Pediatric wide-field fundus photograph: 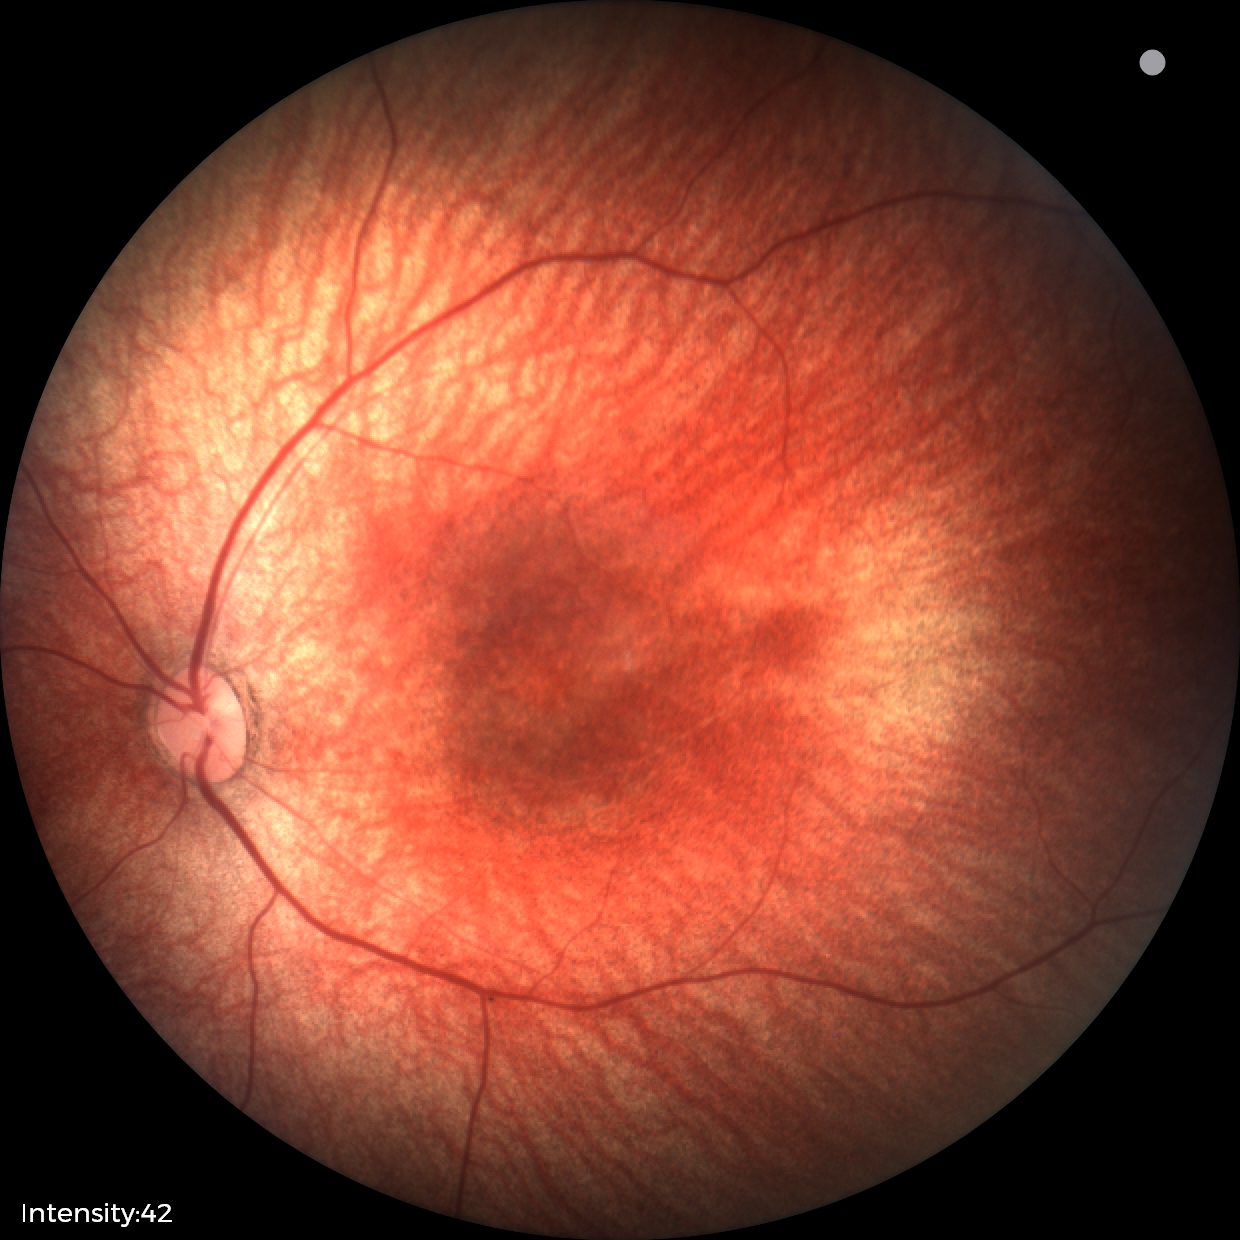 Q: What was the screening finding?
A: physiological finding